45-degree field of view; image size 848x848 — 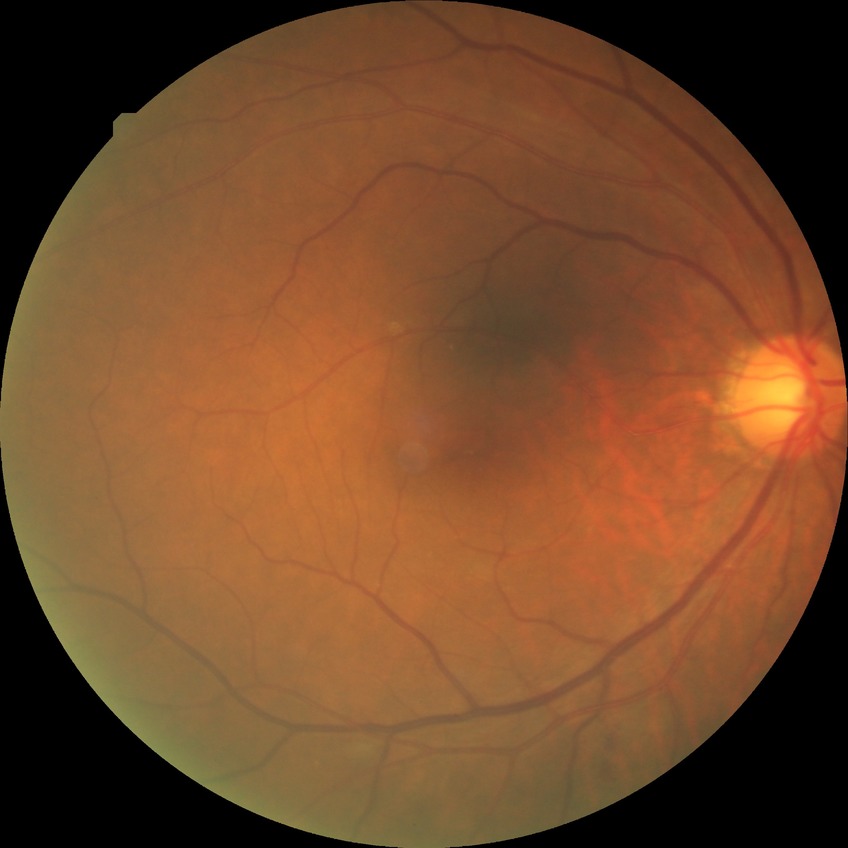 - diabetic retinopathy stage: no diabetic retinopathy